Image size 2089x1764.
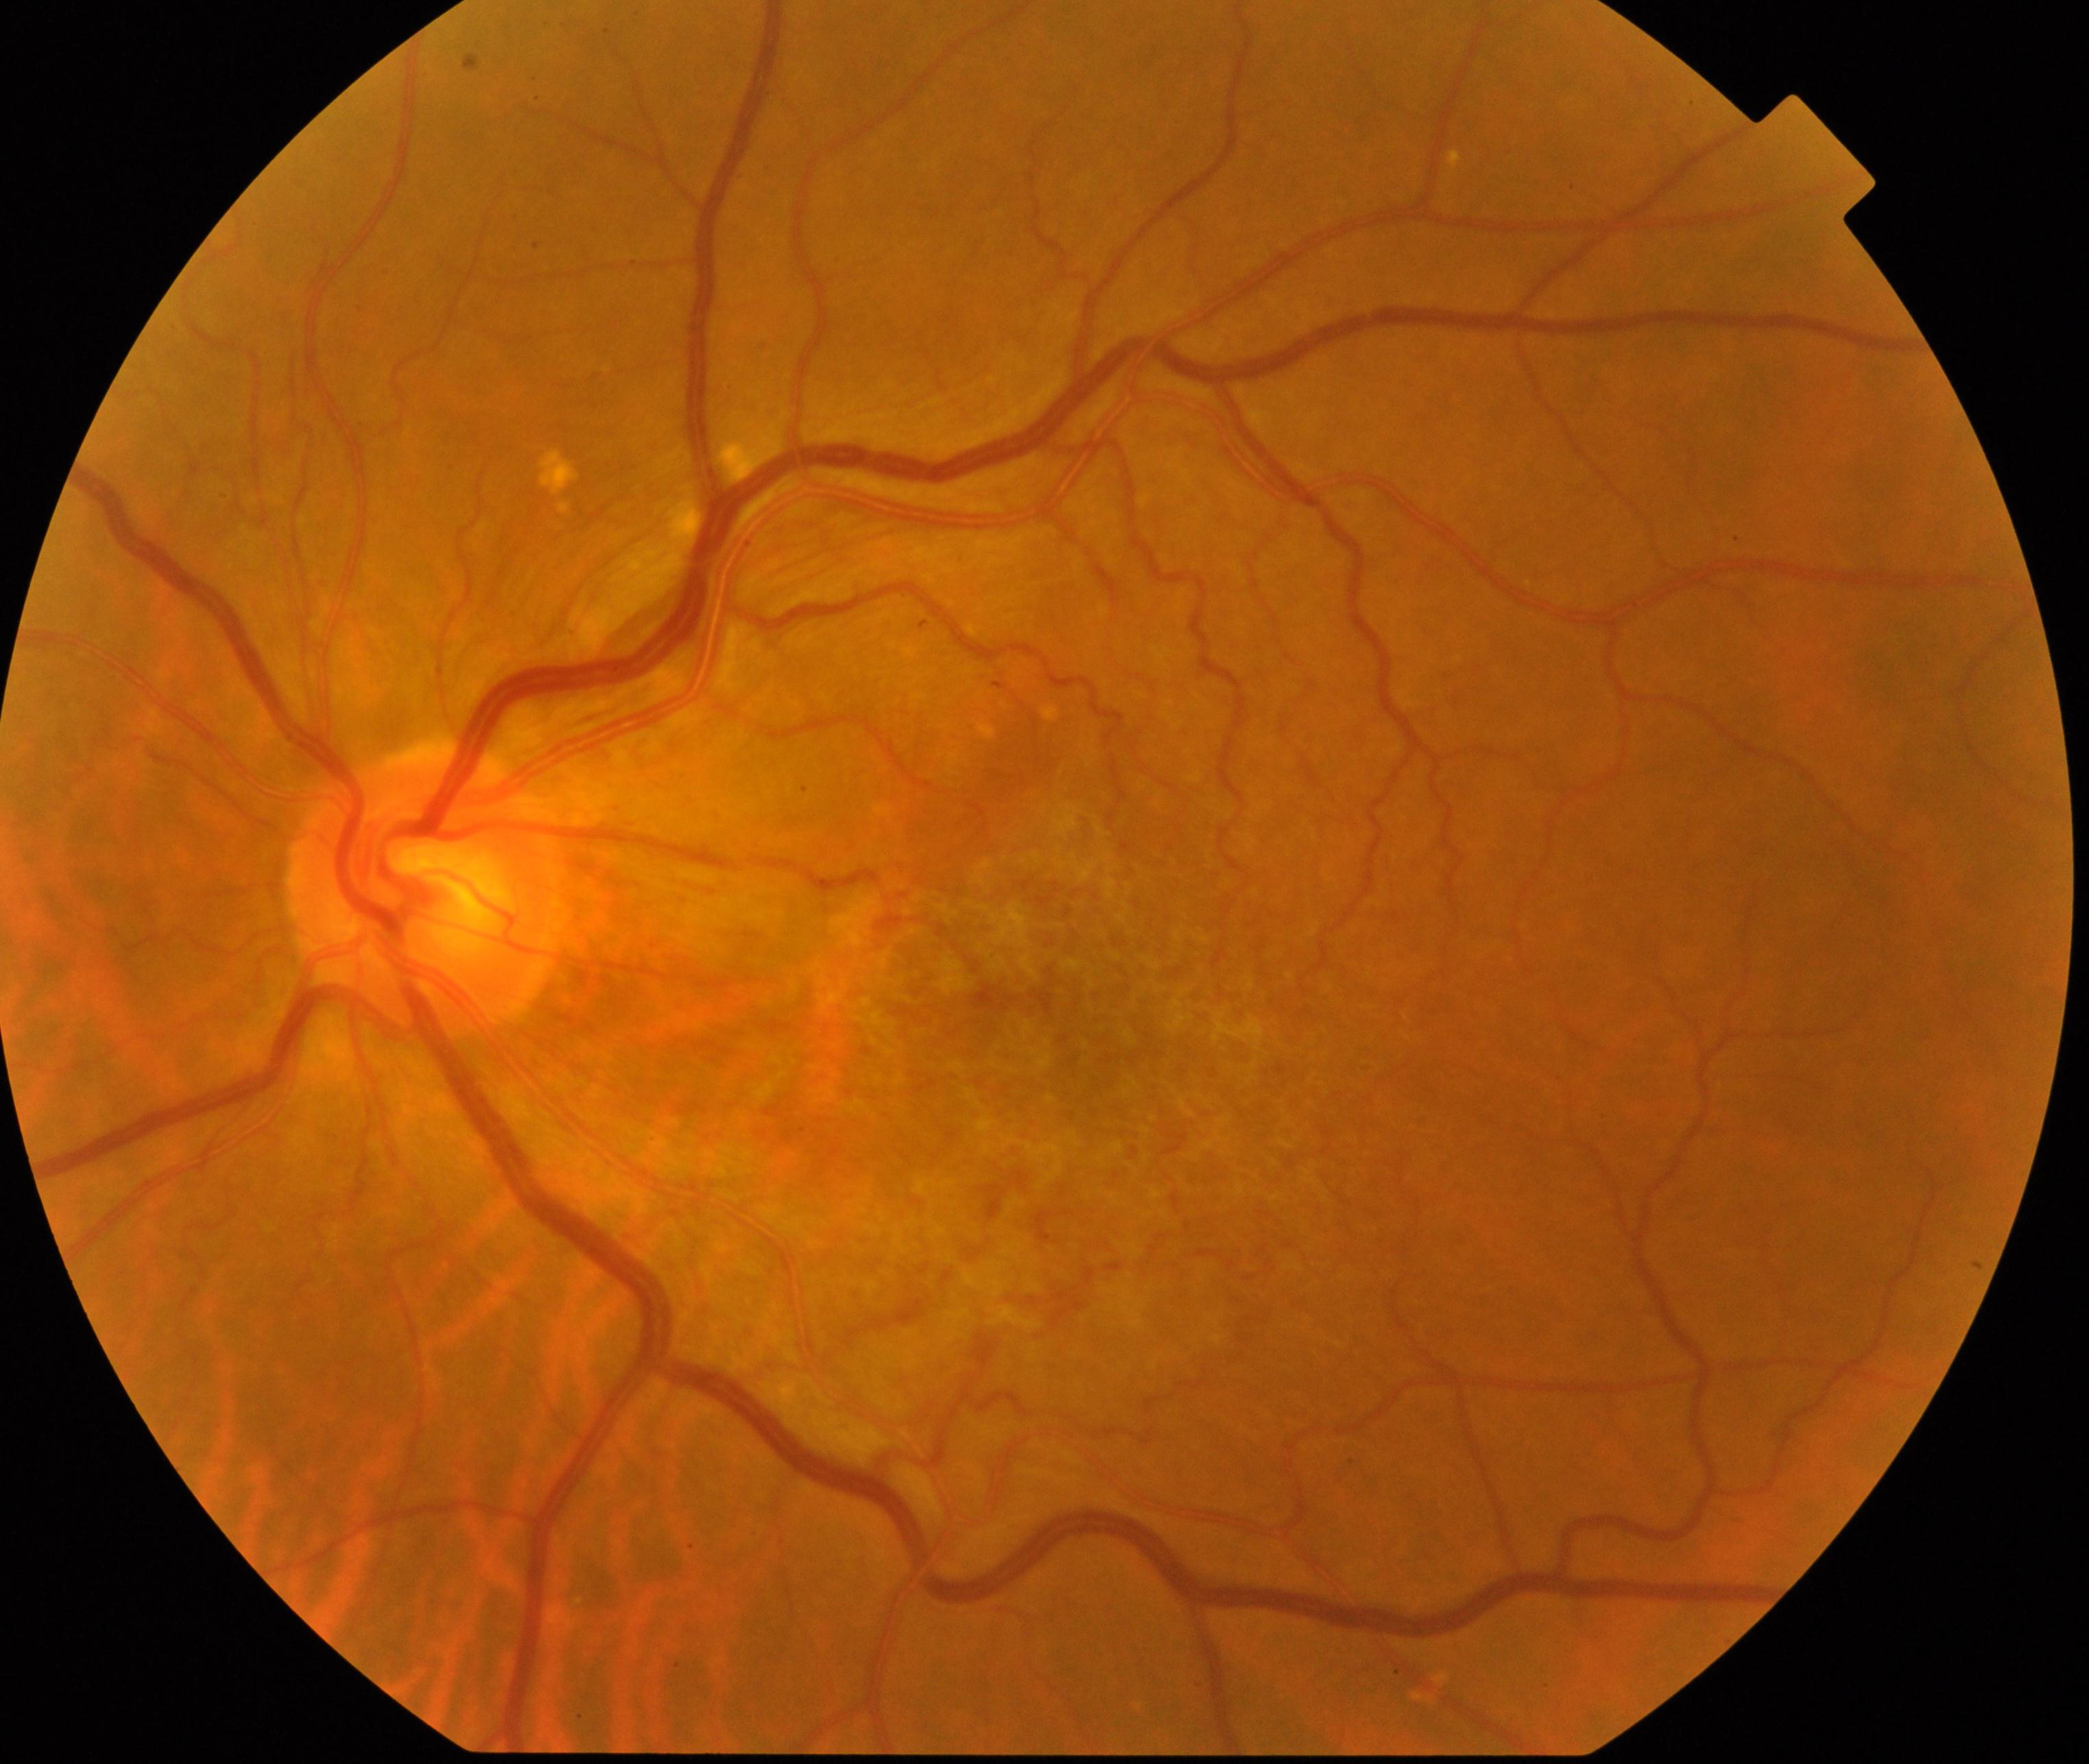

Findings consistent with epiretinal membrane (ERM).